Without pupil dilation; fundus photo.
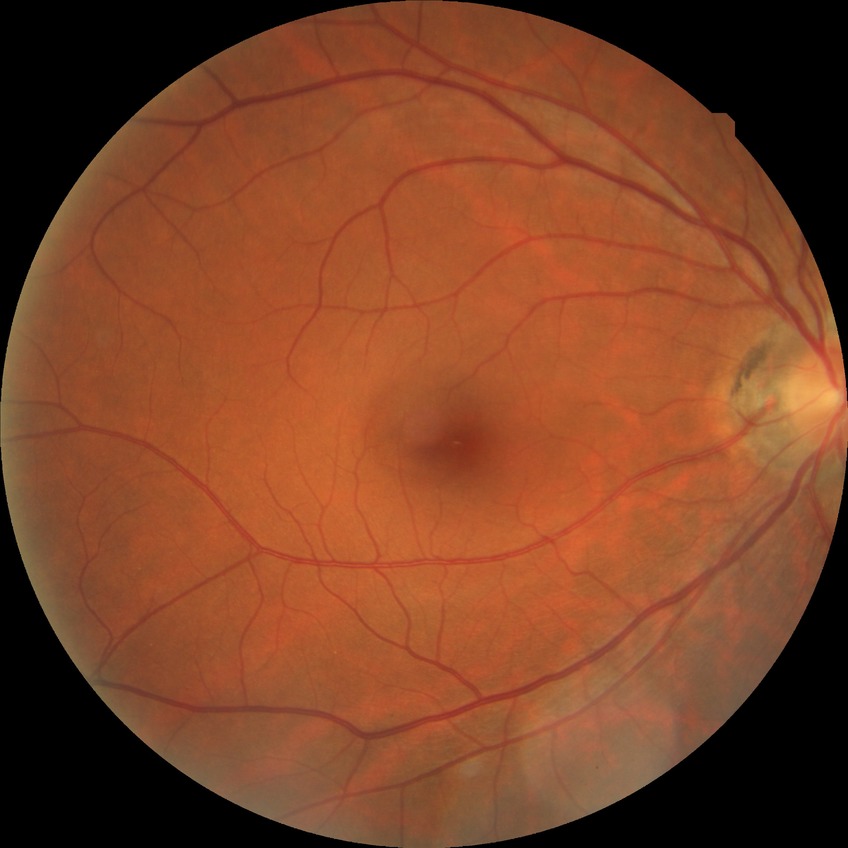 Diabetic retinopathy severity is no diabetic retinopathy.